Image size 1659x2212:
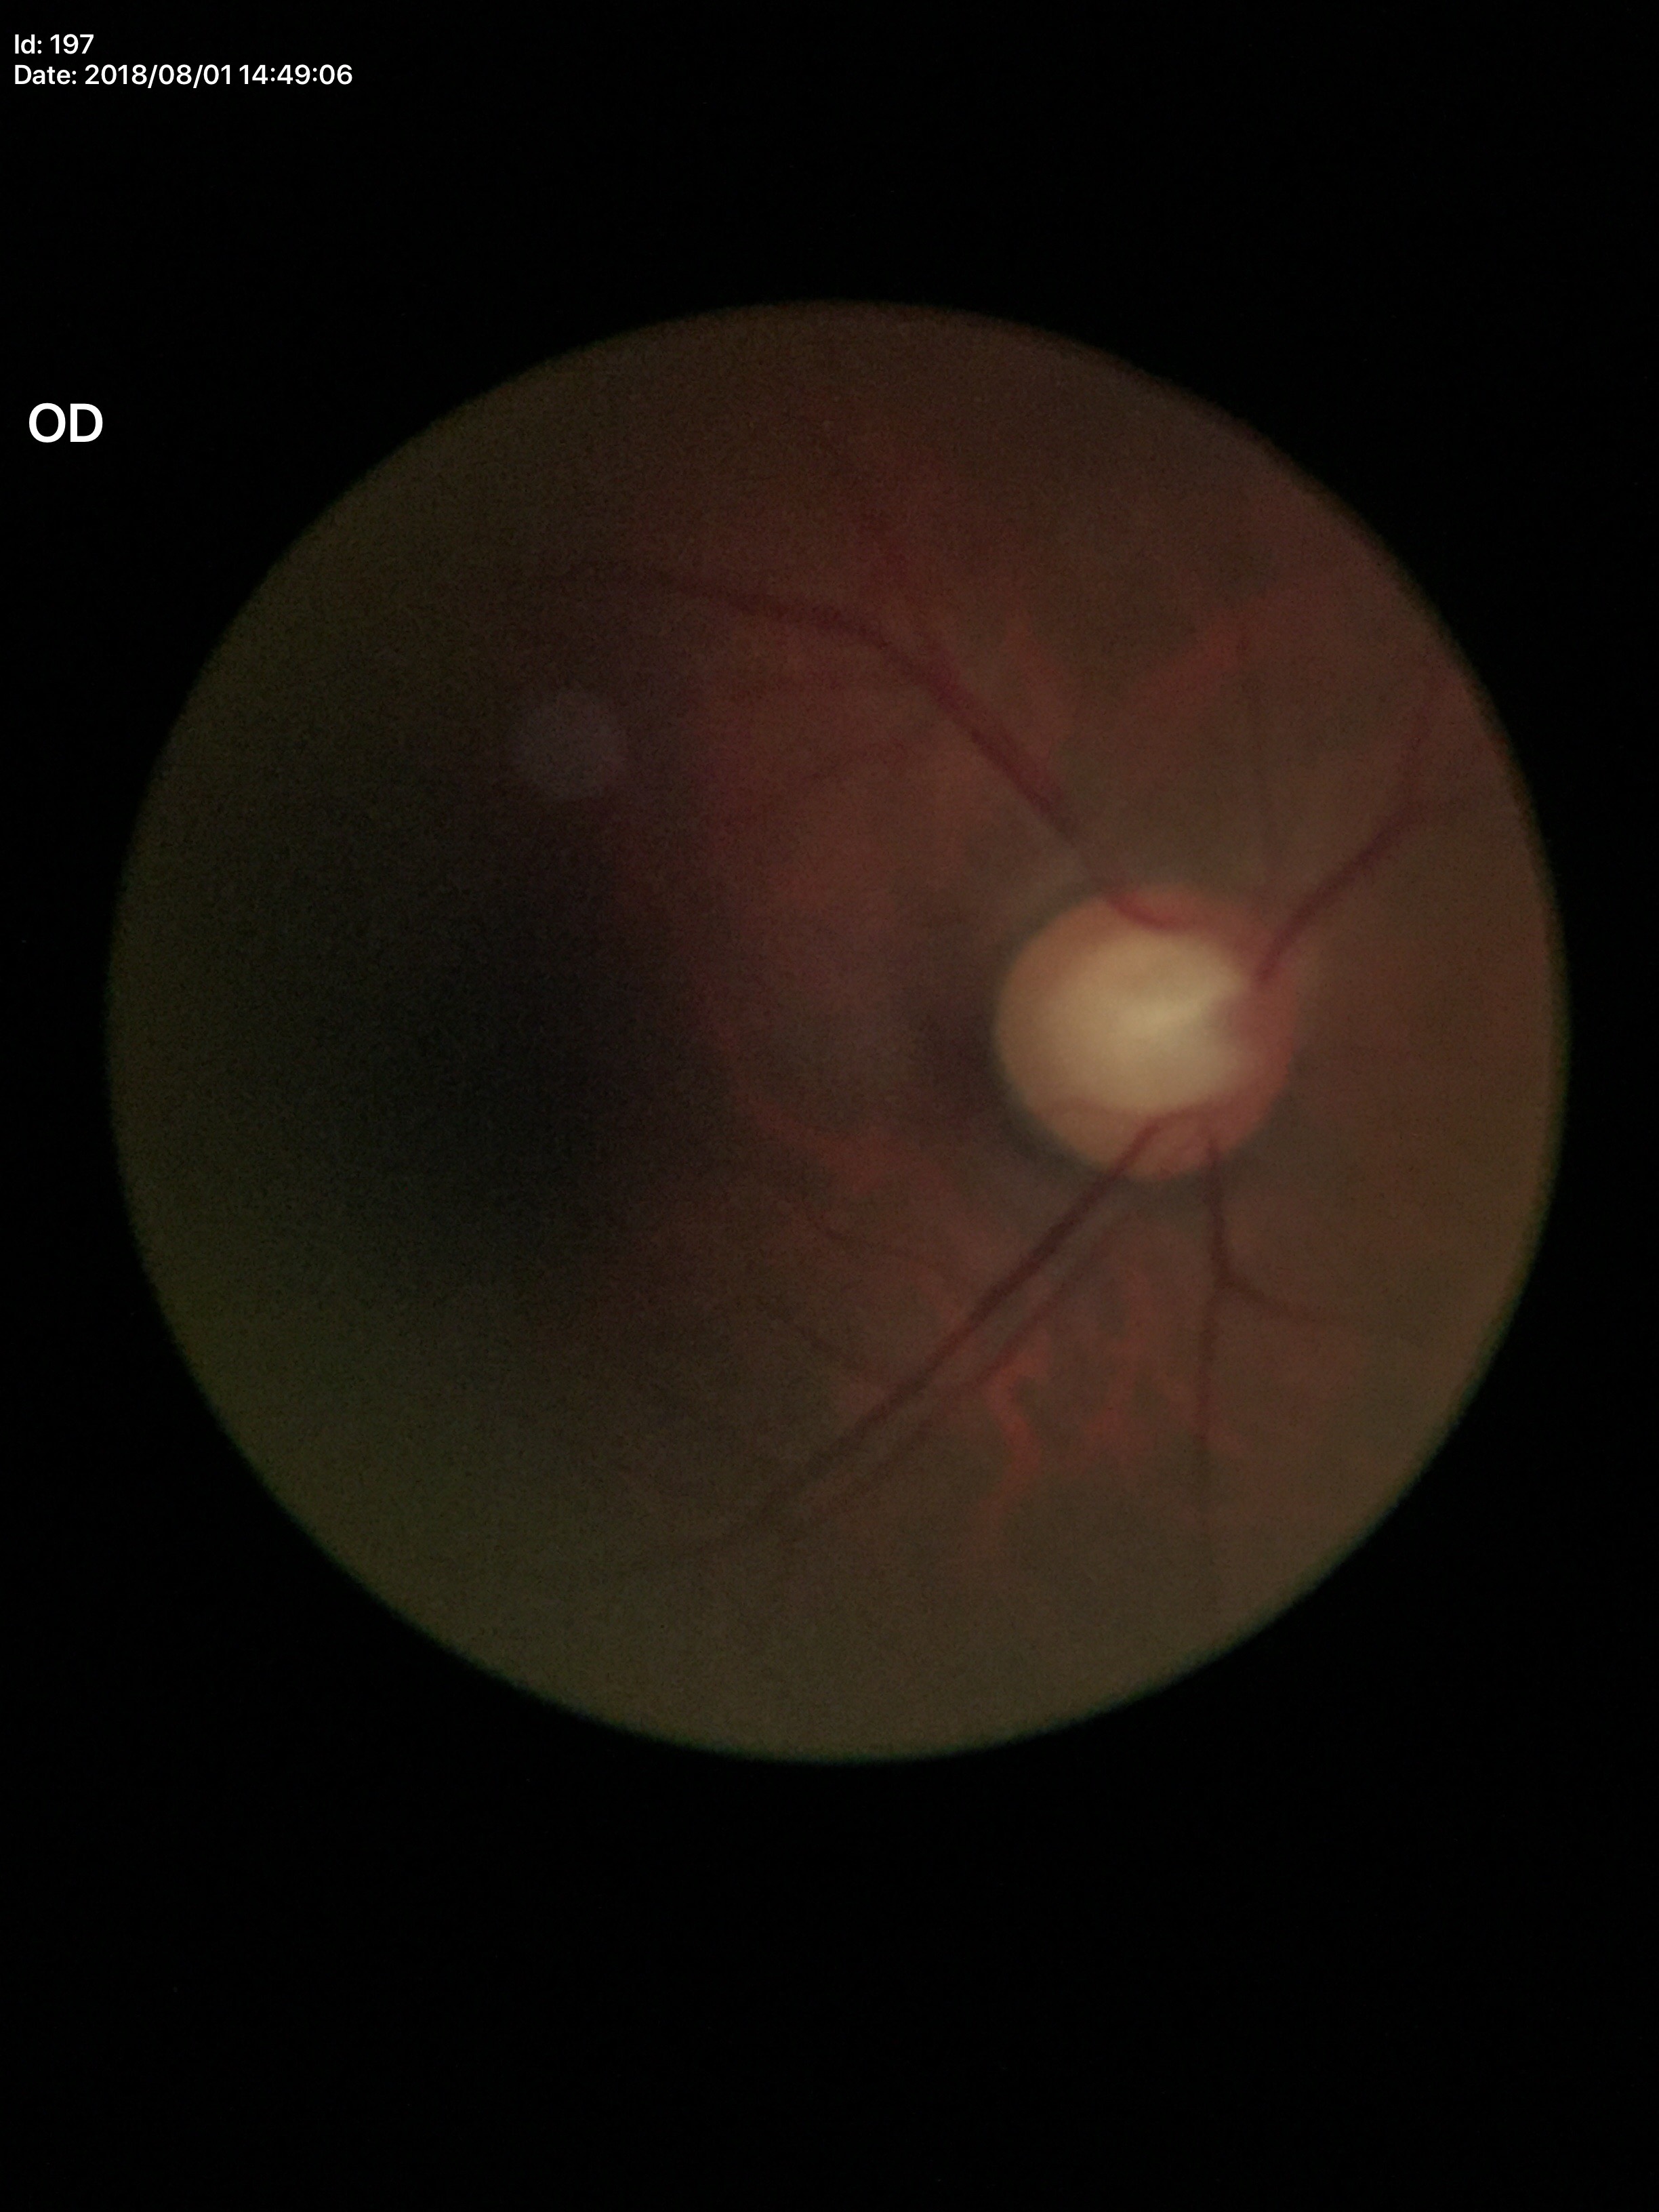
Suspicious for glaucoma. Vertical cup-disc ratio (VCDR) of 0.63.